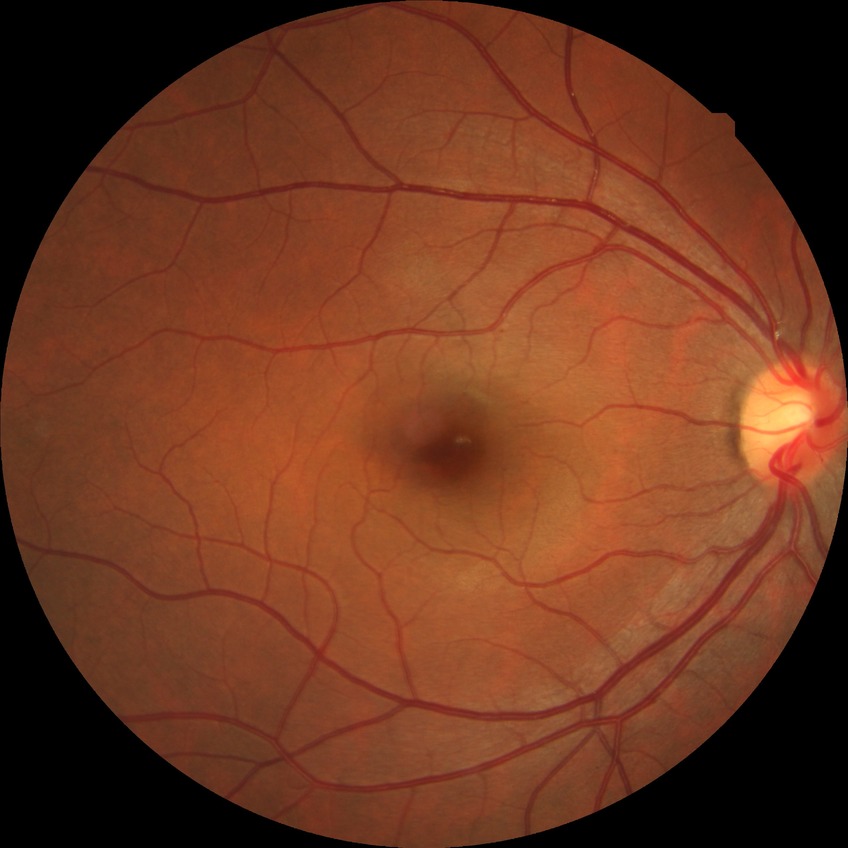
modified Davis classification: no diabetic retinopathy.